Camera: NIDEK AFC-230, fundus photo, image size 848x848, Davis DR grading:
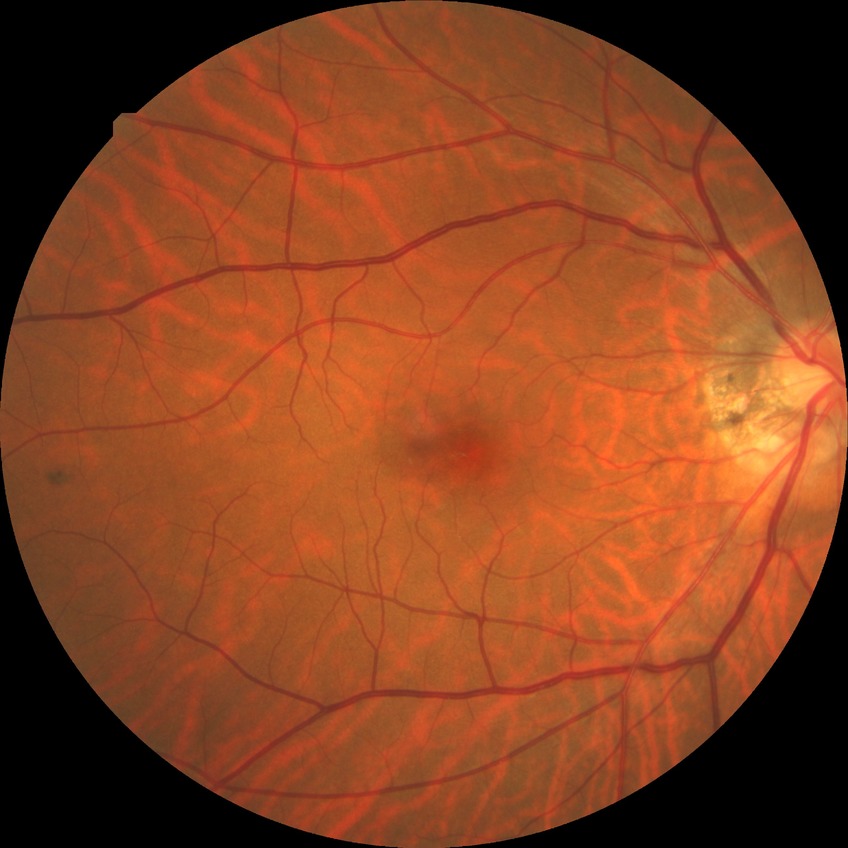

Assessment:
• diabetic retinopathy (DR) — no diabetic retinopathy (NDR)